2048x1536.
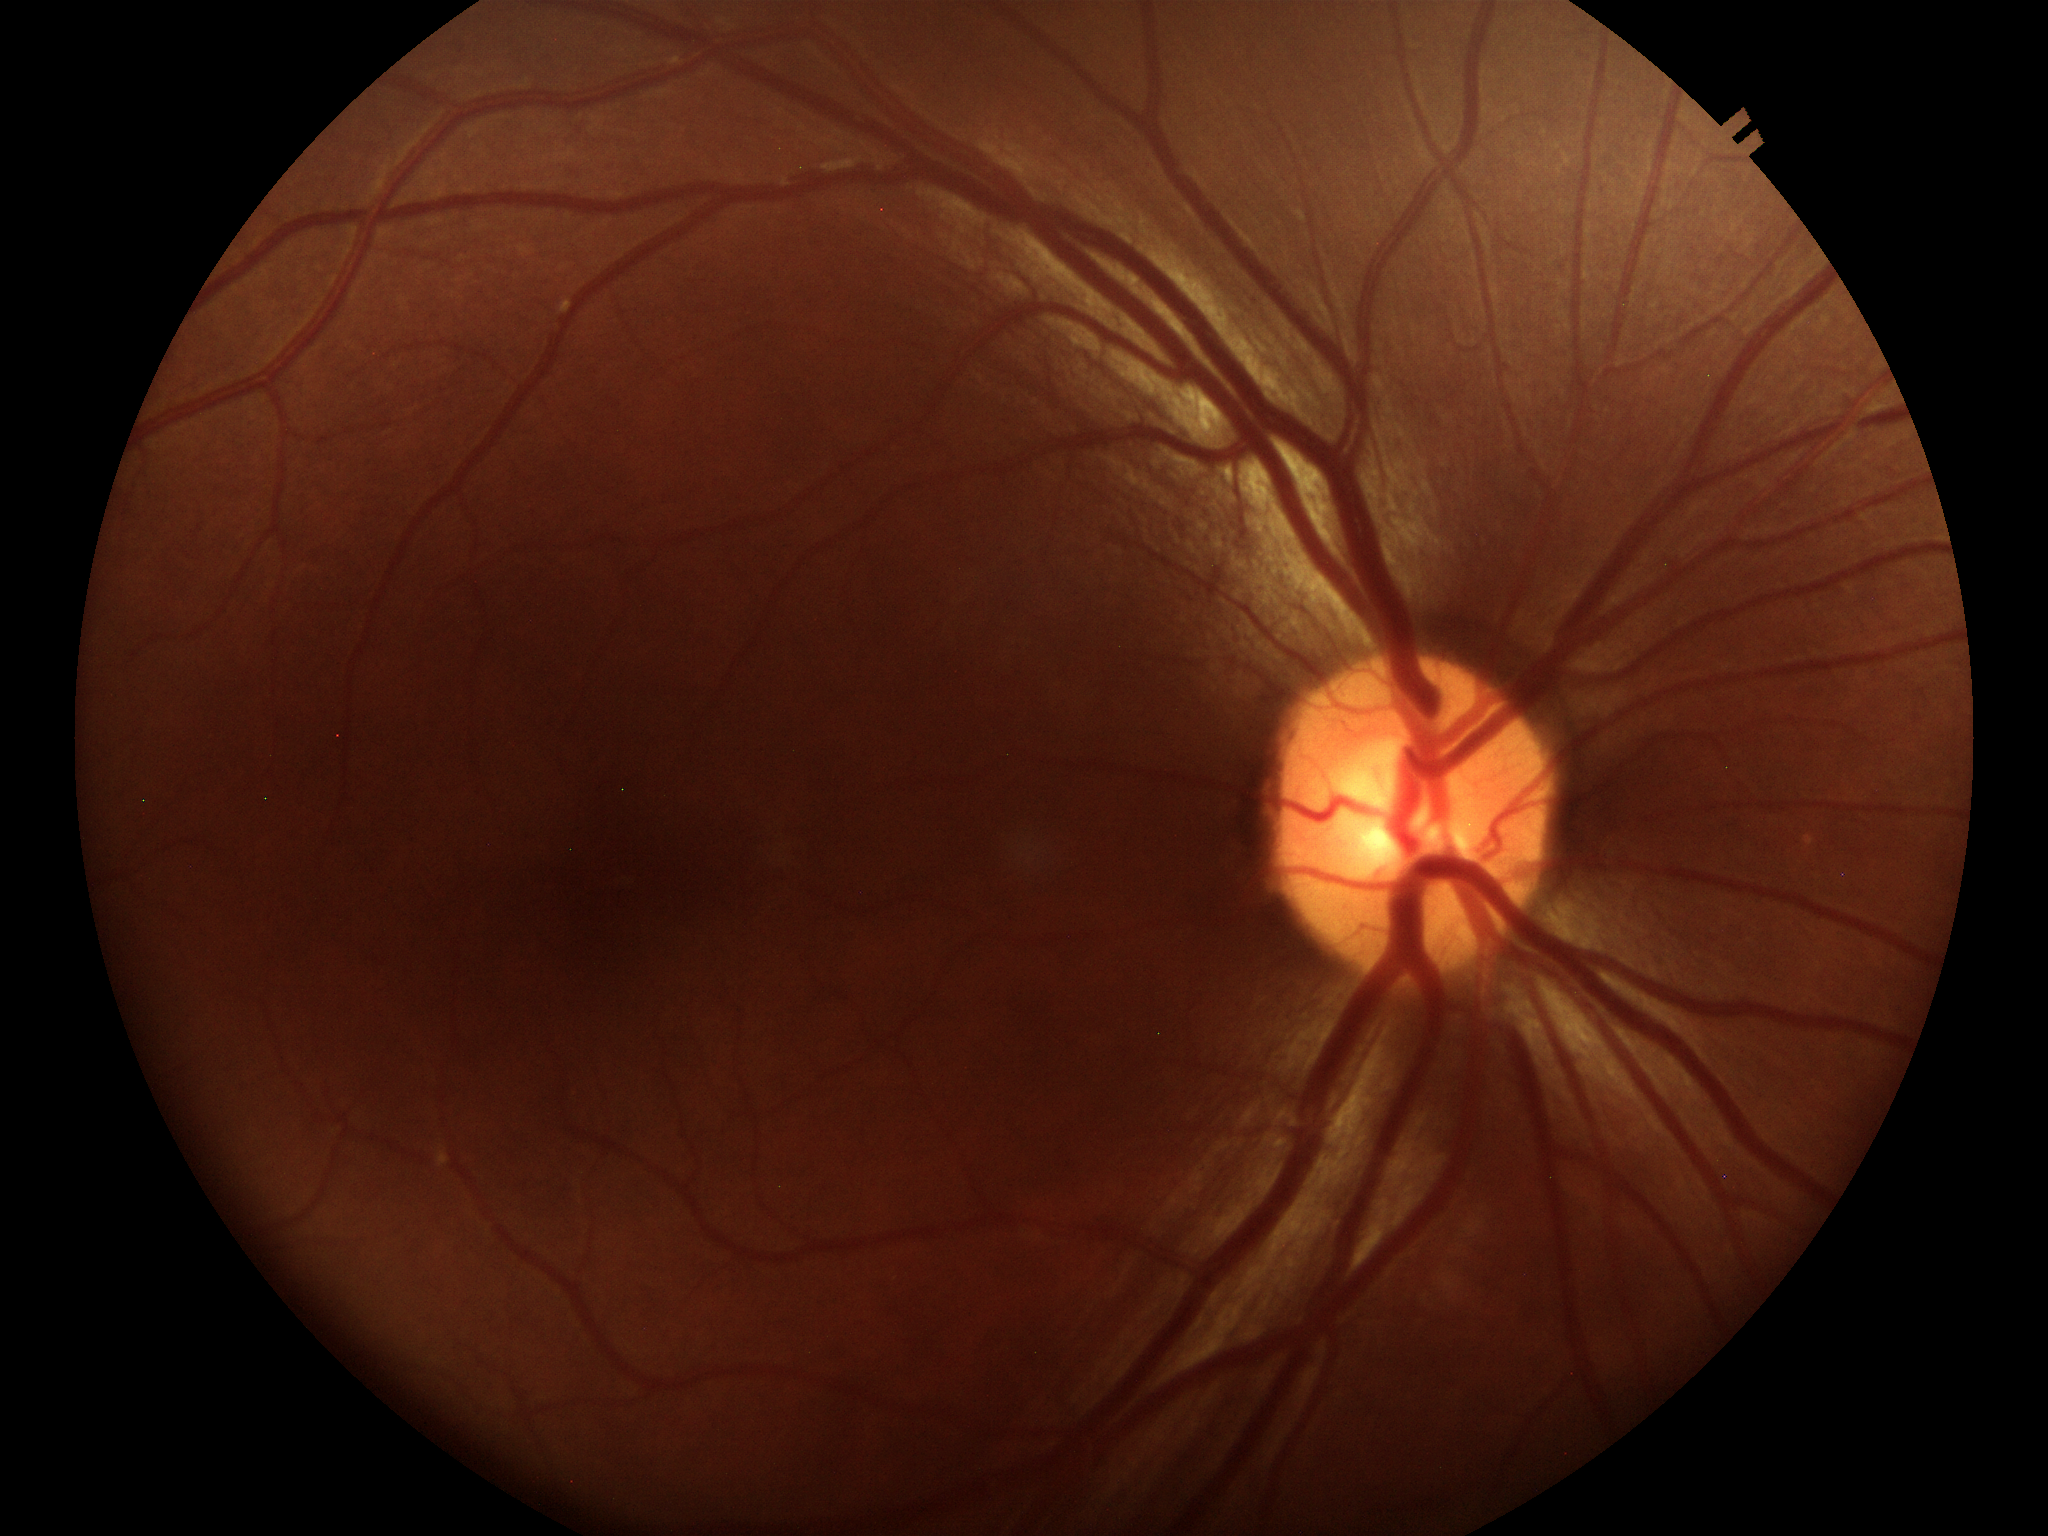
No glaucomatous findings.
VCDR: 0.50.
HCDR is 0.51.